640x480px. Wide-field contact fundus photograph of an infant:
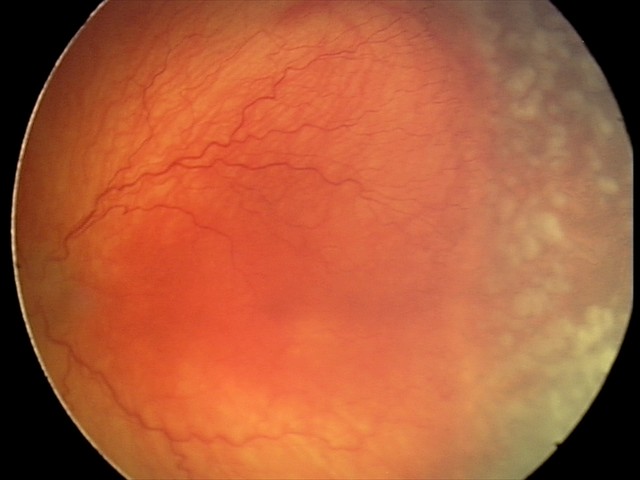

Series diagnosed as aggressive ROP (A-ROP) — rapidly progressive severe ROP with prominent plus disease, often without classic stage progression.